Color fundus photograph.
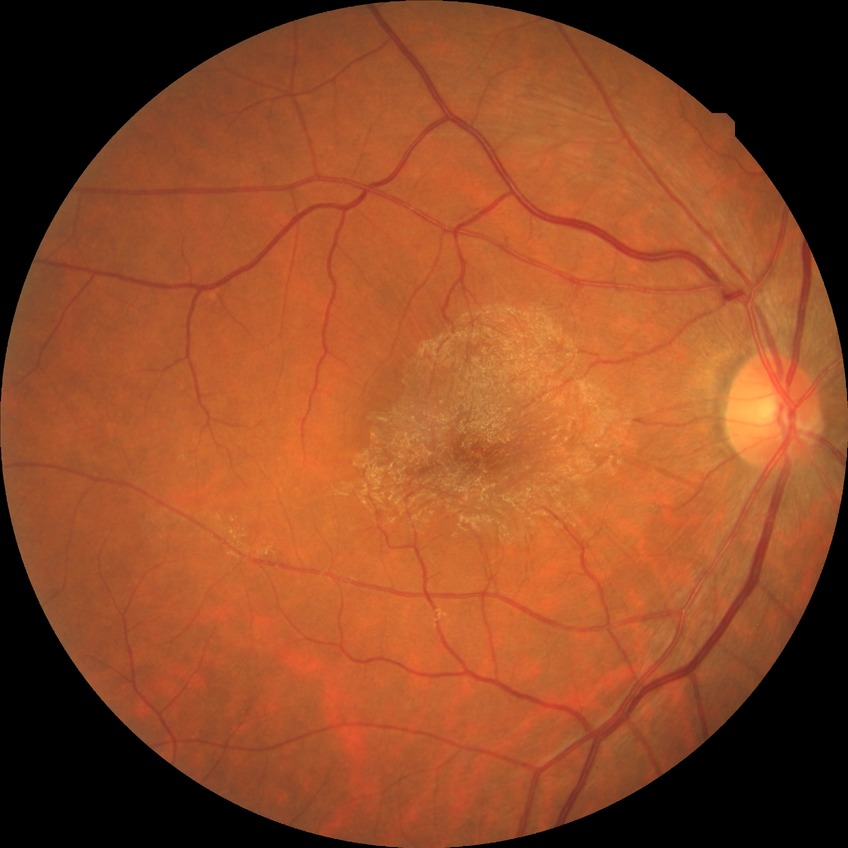

diabetic retinopathy (DR) = no diabetic retinopathy (NDR)